Wide-field fundus photograph from neonatal ROP screening:
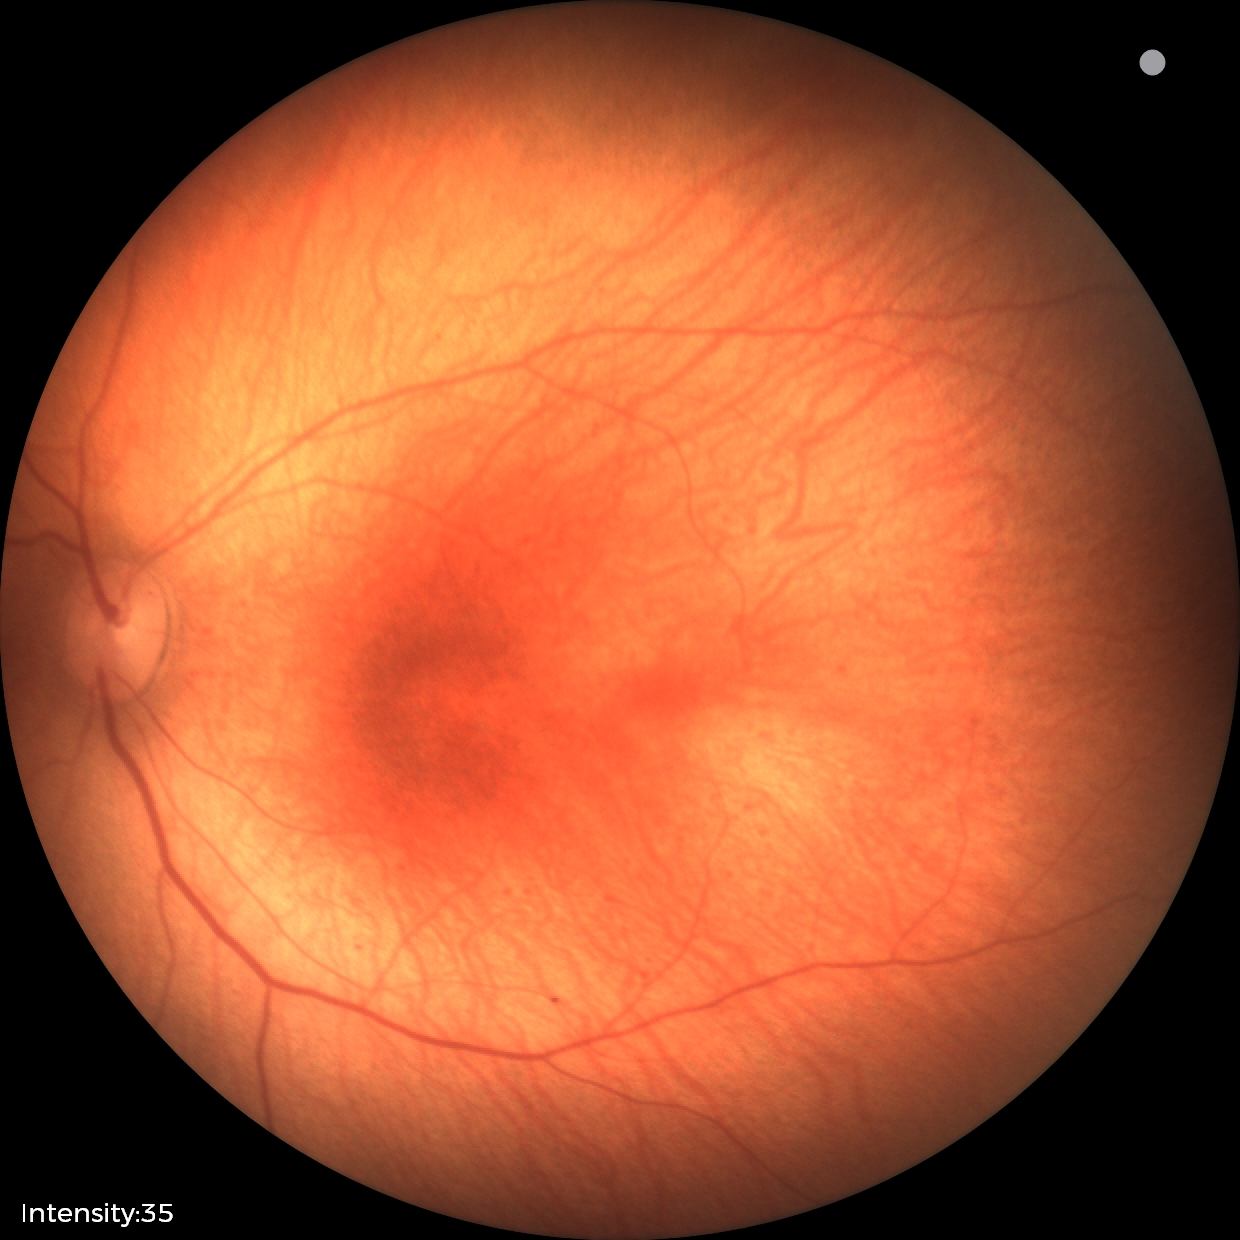

Examination with physiological retinal findings.